Fundus photo, acquired with a NIDEK AFC-230:
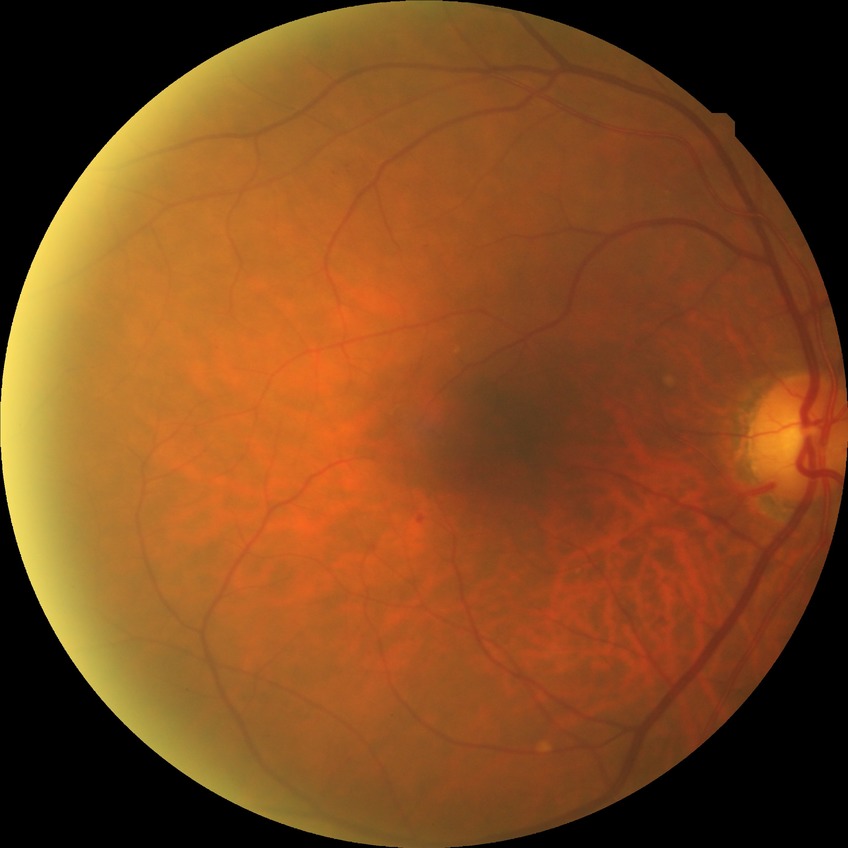
diabetic retinopathy (DR): NDR (no diabetic retinopathy).